45-degree field of view · color fundus image · 2212x1659px: 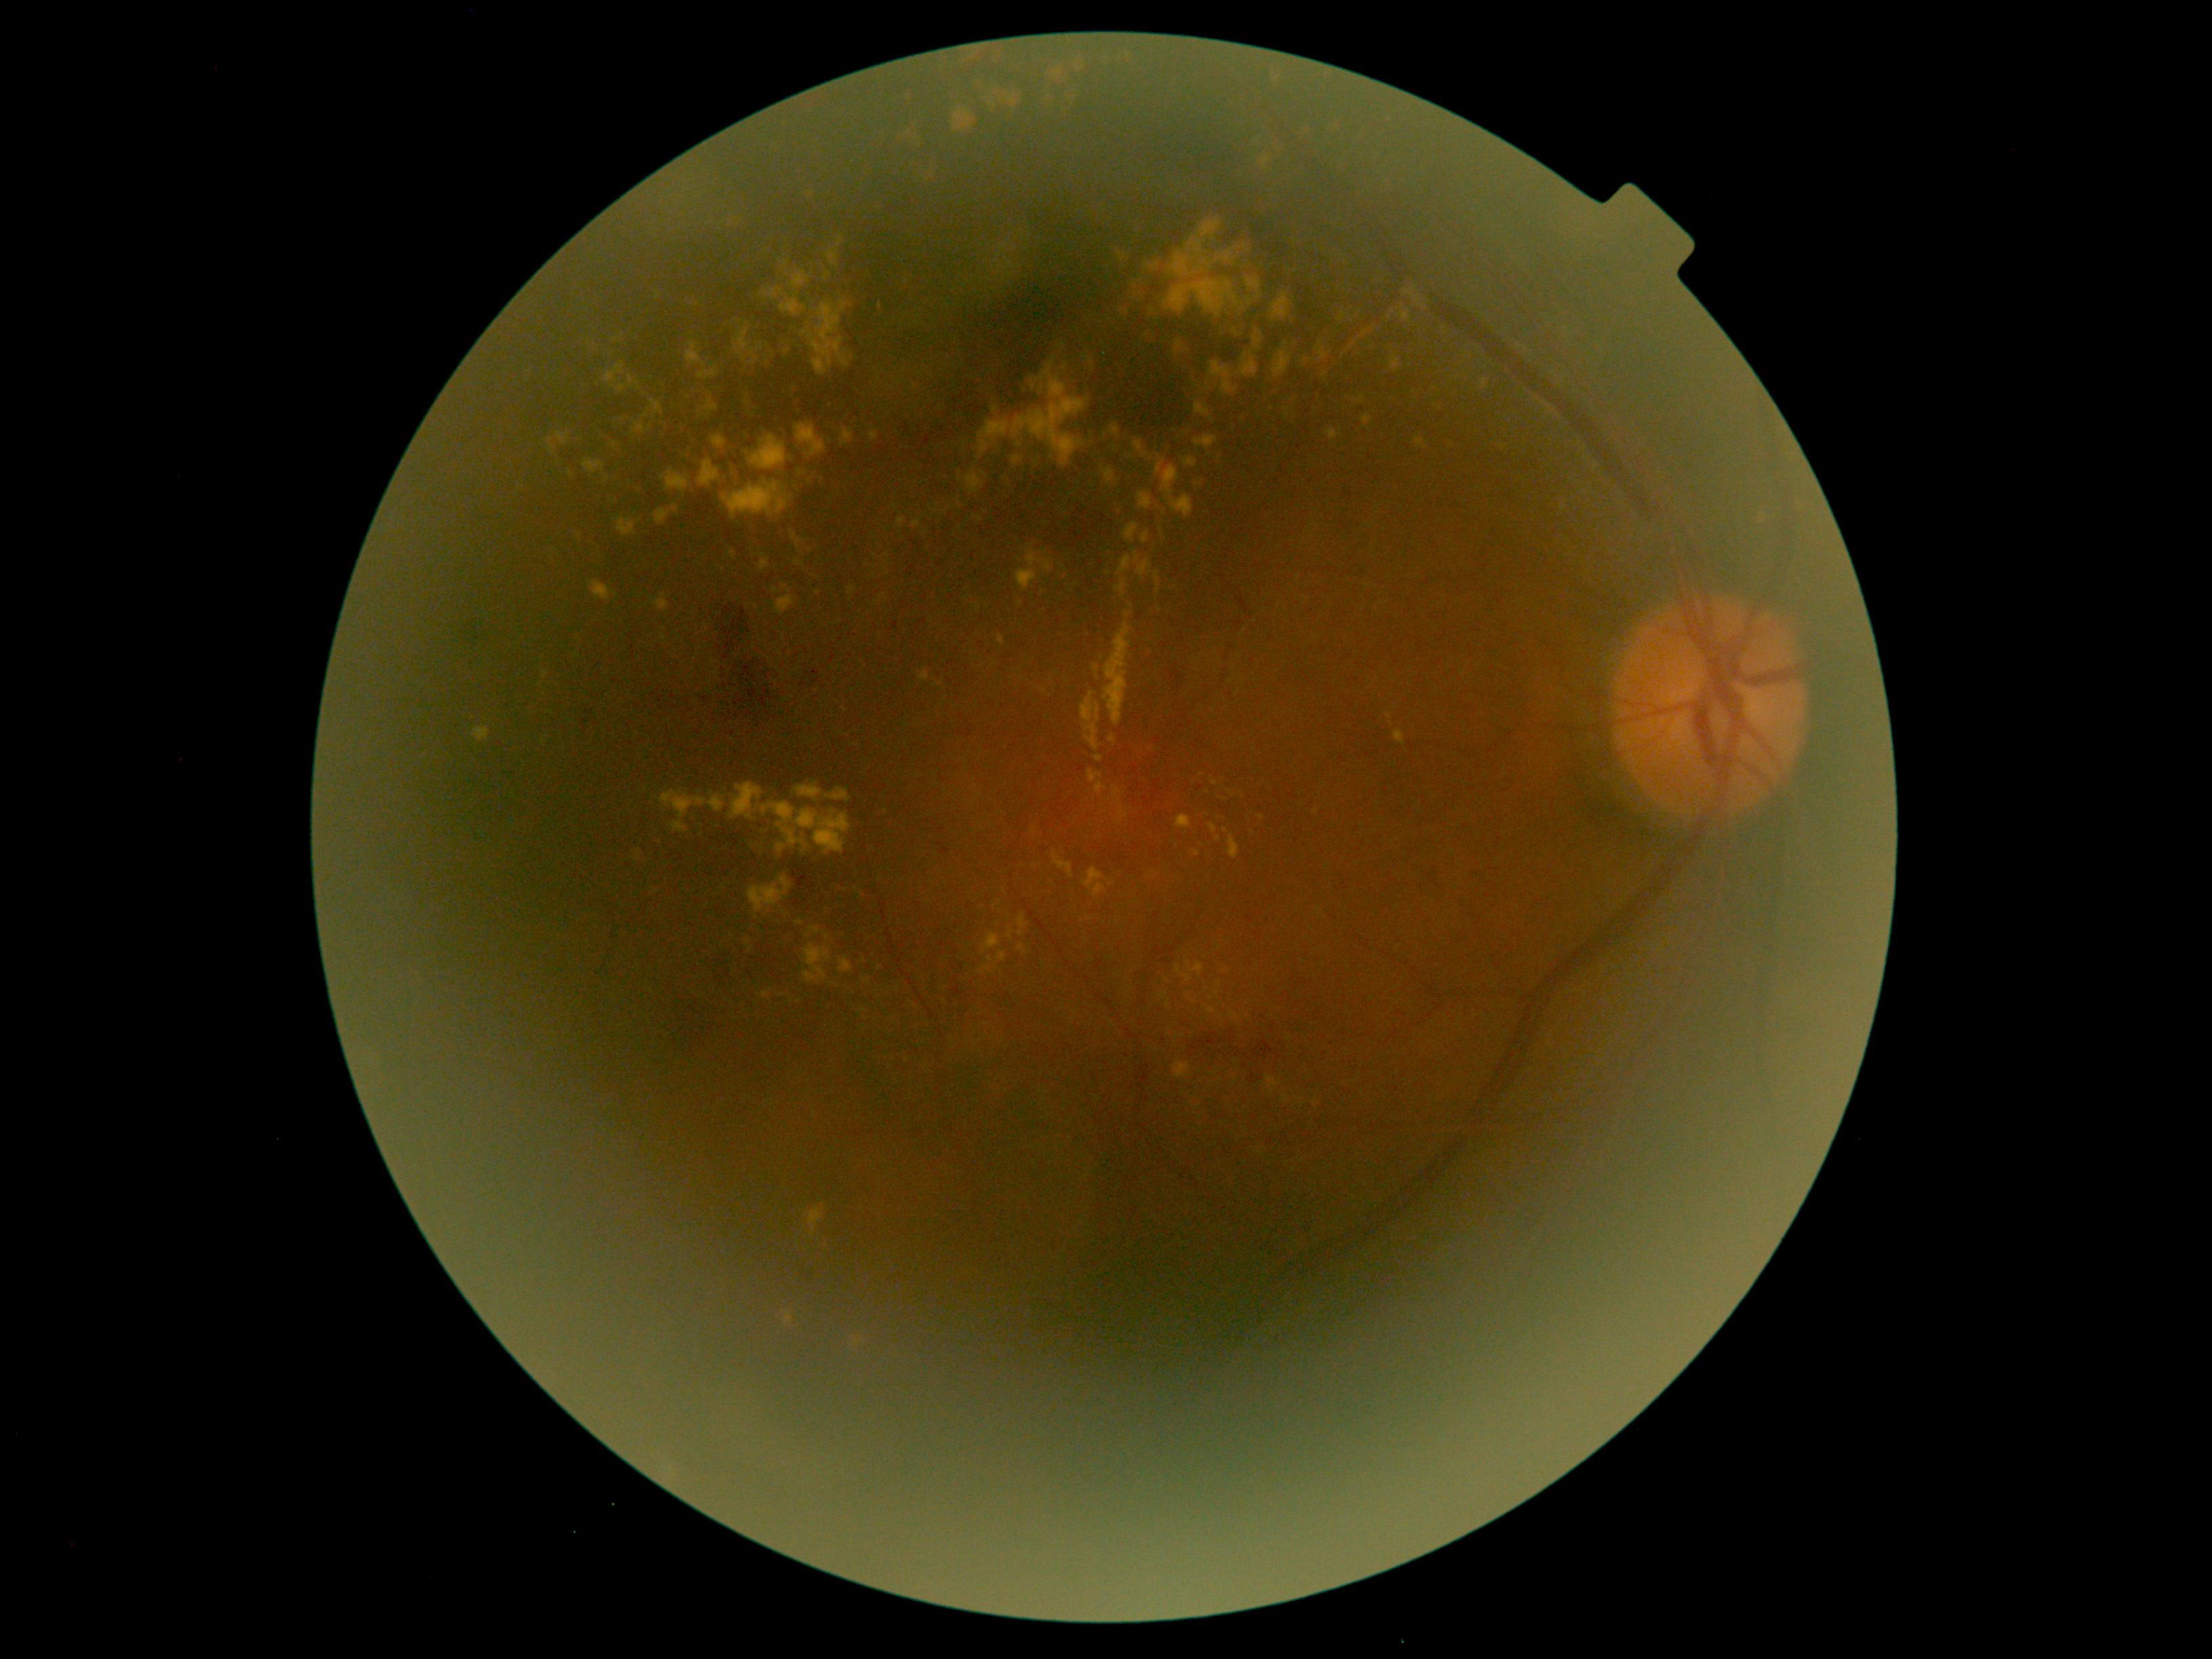
Retinopathy grade is 2 (moderate NPDR)
Lesions identified (partial list):
hard exudates (partial) = rect(1017, 916, 1029, 937) | rect(747, 878, 792, 914) | rect(773, 588, 781, 594) | rect(1008, 930, 1015, 941) | rect(1012, 456, 1021, 466) | rect(1215, 253, 1234, 264) | rect(851, 1337, 861, 1348) | rect(1176, 966, 1181, 974) | rect(981, 933, 1002, 955) | rect(1260, 157, 1272, 169) | rect(1753, 510, 1772, 529) | rect(775, 583, 796, 616)
Small hard exudates near 1090/919 | 995/409 | 826/936 | 786/915 | 862/895 | 1114/449 | 1225/831